Diabetic retinopathy graded by the modified Davis classification. 45° FOV: 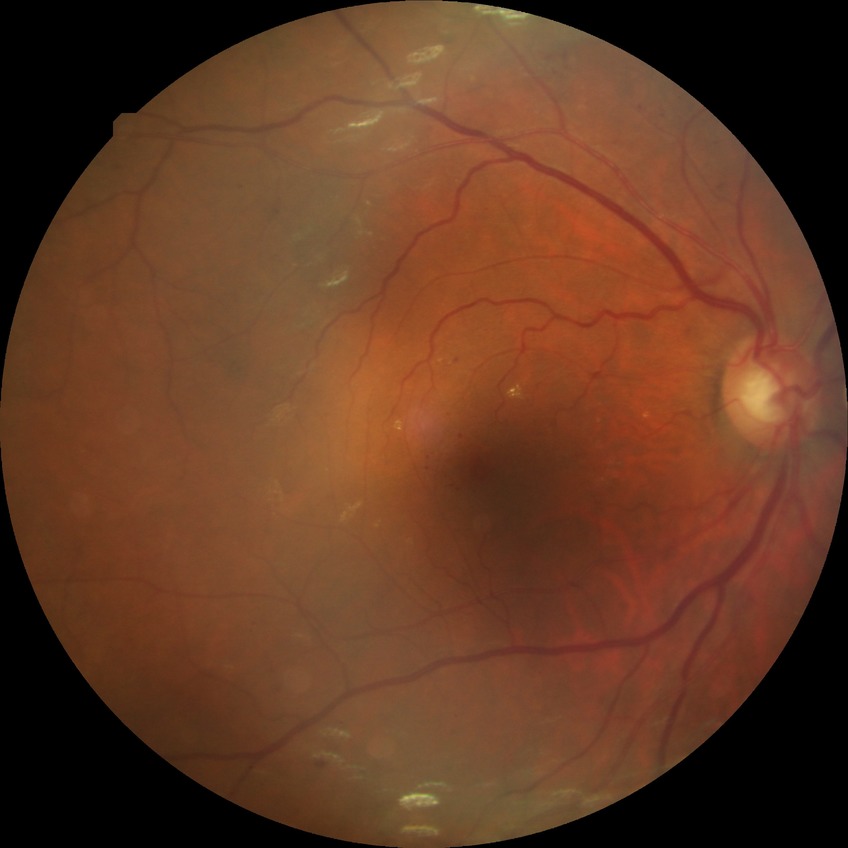

Assessment:
• diabetic retinopathy (DR): SDR (simple diabetic retinopathy)